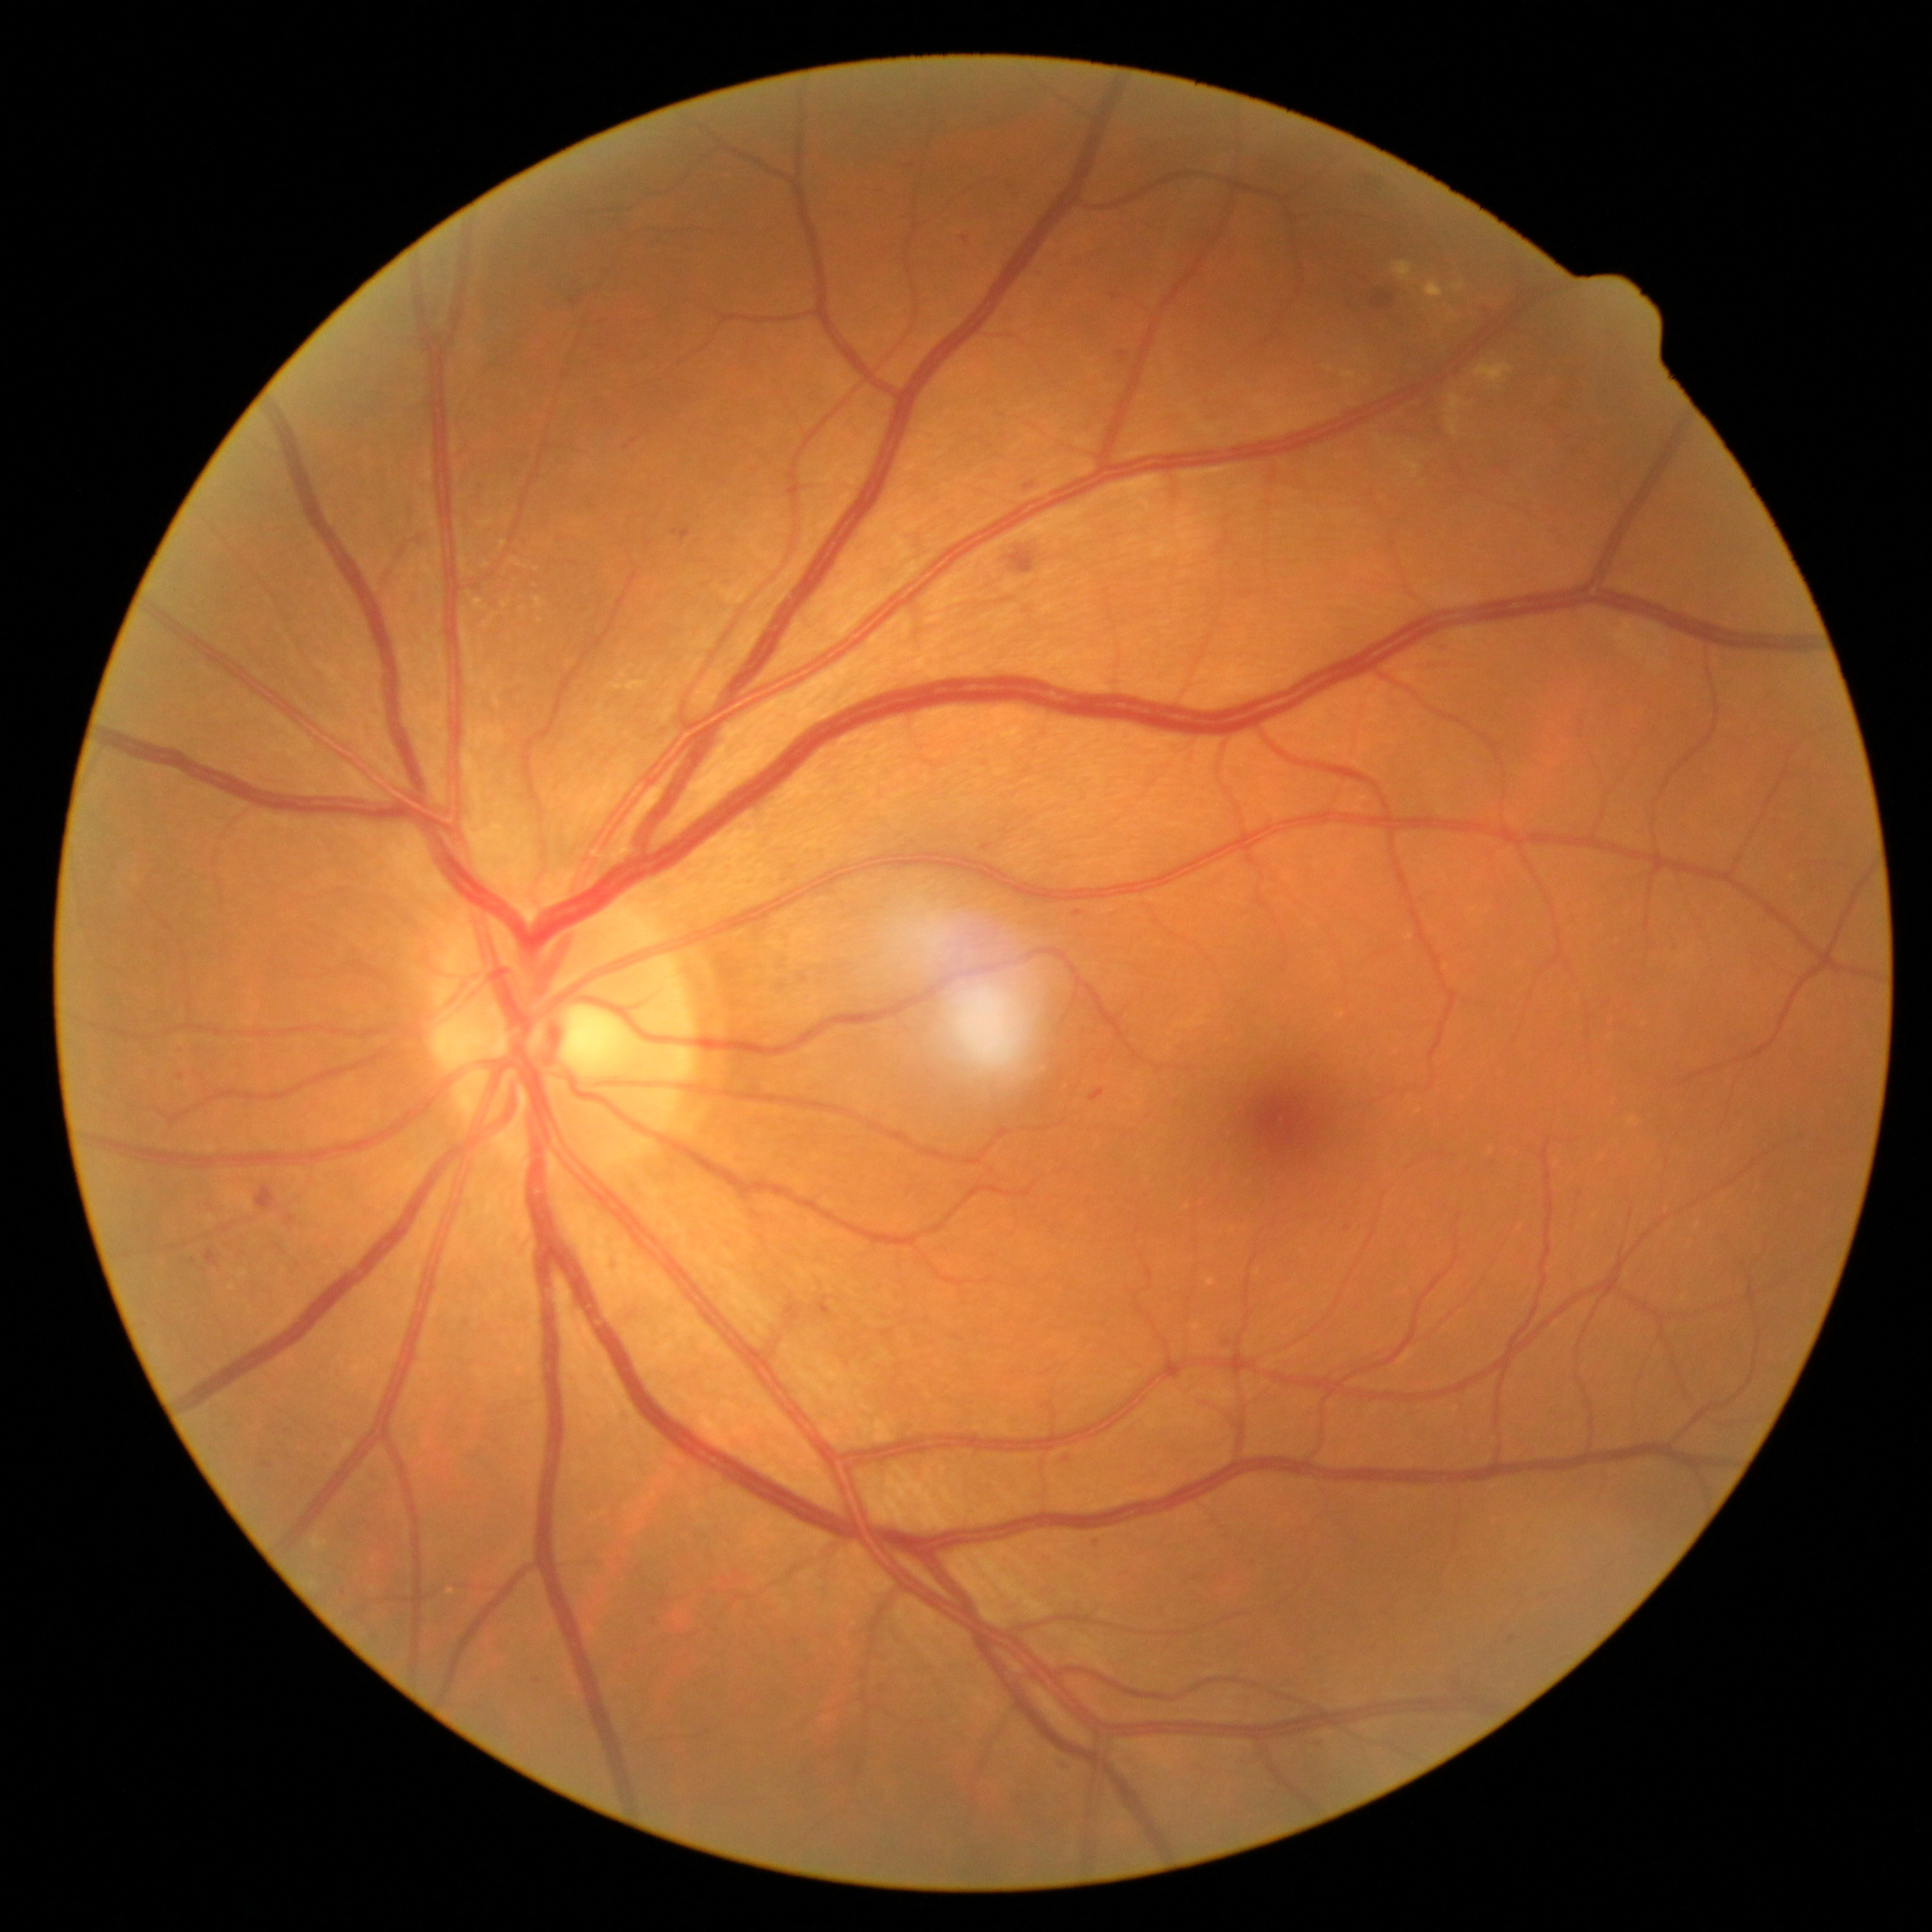

Diabetic retinopathy (DR) is moderate NPDR (grade 2); non-proliferative diabetic retinopathy
A subset of detected lesions:
* hemorrhages (HEs): (left=566, top=281, right=585, bottom=305); (left=1009, top=551, right=1034, bottom=574); (left=257, top=1186, right=277, bottom=1211); (left=1018, top=475, right=1039, bottom=491); (left=788, top=1304, right=800, bottom=1321); (left=981, top=846, right=990, bottom=851); (left=1090, top=1088, right=1104, bottom=1101); (left=818, top=1298, right=830, bottom=1315); (left=1372, top=293, right=1396, bottom=310); (left=206, top=1251, right=221, bottom=1268); (left=287, top=1216, right=298, bottom=1225)
* hard exudates (EXs) (subset): (left=1447, top=418, right=1461, bottom=435); (left=1447, top=394, right=1464, bottom=414); (left=503, top=601, right=510, bottom=609); (left=475, top=599, right=488, bottom=612); (left=1453, top=282, right=1464, bottom=291); (left=609, top=669, right=652, bottom=693); (left=1399, top=457, right=1420, bottom=479); (left=478, top=518, right=494, bottom=527); (left=1447, top=311, right=1461, bottom=320)
* Smaller EXs around (1378,437); (523,610); (461,545); (1389,442); (537,569); (487,565); (1366,382)
* microaneurysms (MAs): (left=1074, top=911, right=1083, bottom=916); (left=1318, top=1740, right=1327, bottom=1749); (left=1092, top=1535, right=1101, bottom=1543); (left=1346, top=1221, right=1352, bottom=1233); (left=1225, top=1337, right=1232, bottom=1348); (left=1512, top=1628, right=1520, bottom=1643); (left=1483, top=305, right=1491, bottom=315); (left=1116, top=351, right=1129, bottom=361); (left=962, top=235, right=969, bottom=243); (left=179, top=1074, right=184, bottom=1082); (left=1064, top=1457, right=1072, bottom=1463); (left=681, top=529, right=692, bottom=542); (left=1057, top=1761, right=1074, bottom=1768); (left=262, top=1463, right=272, bottom=1469)
* Smaller MAs around (1497,468); (910,165); (1030,486)
* soft exudates (SEs): not present